Image size 1659x2212:
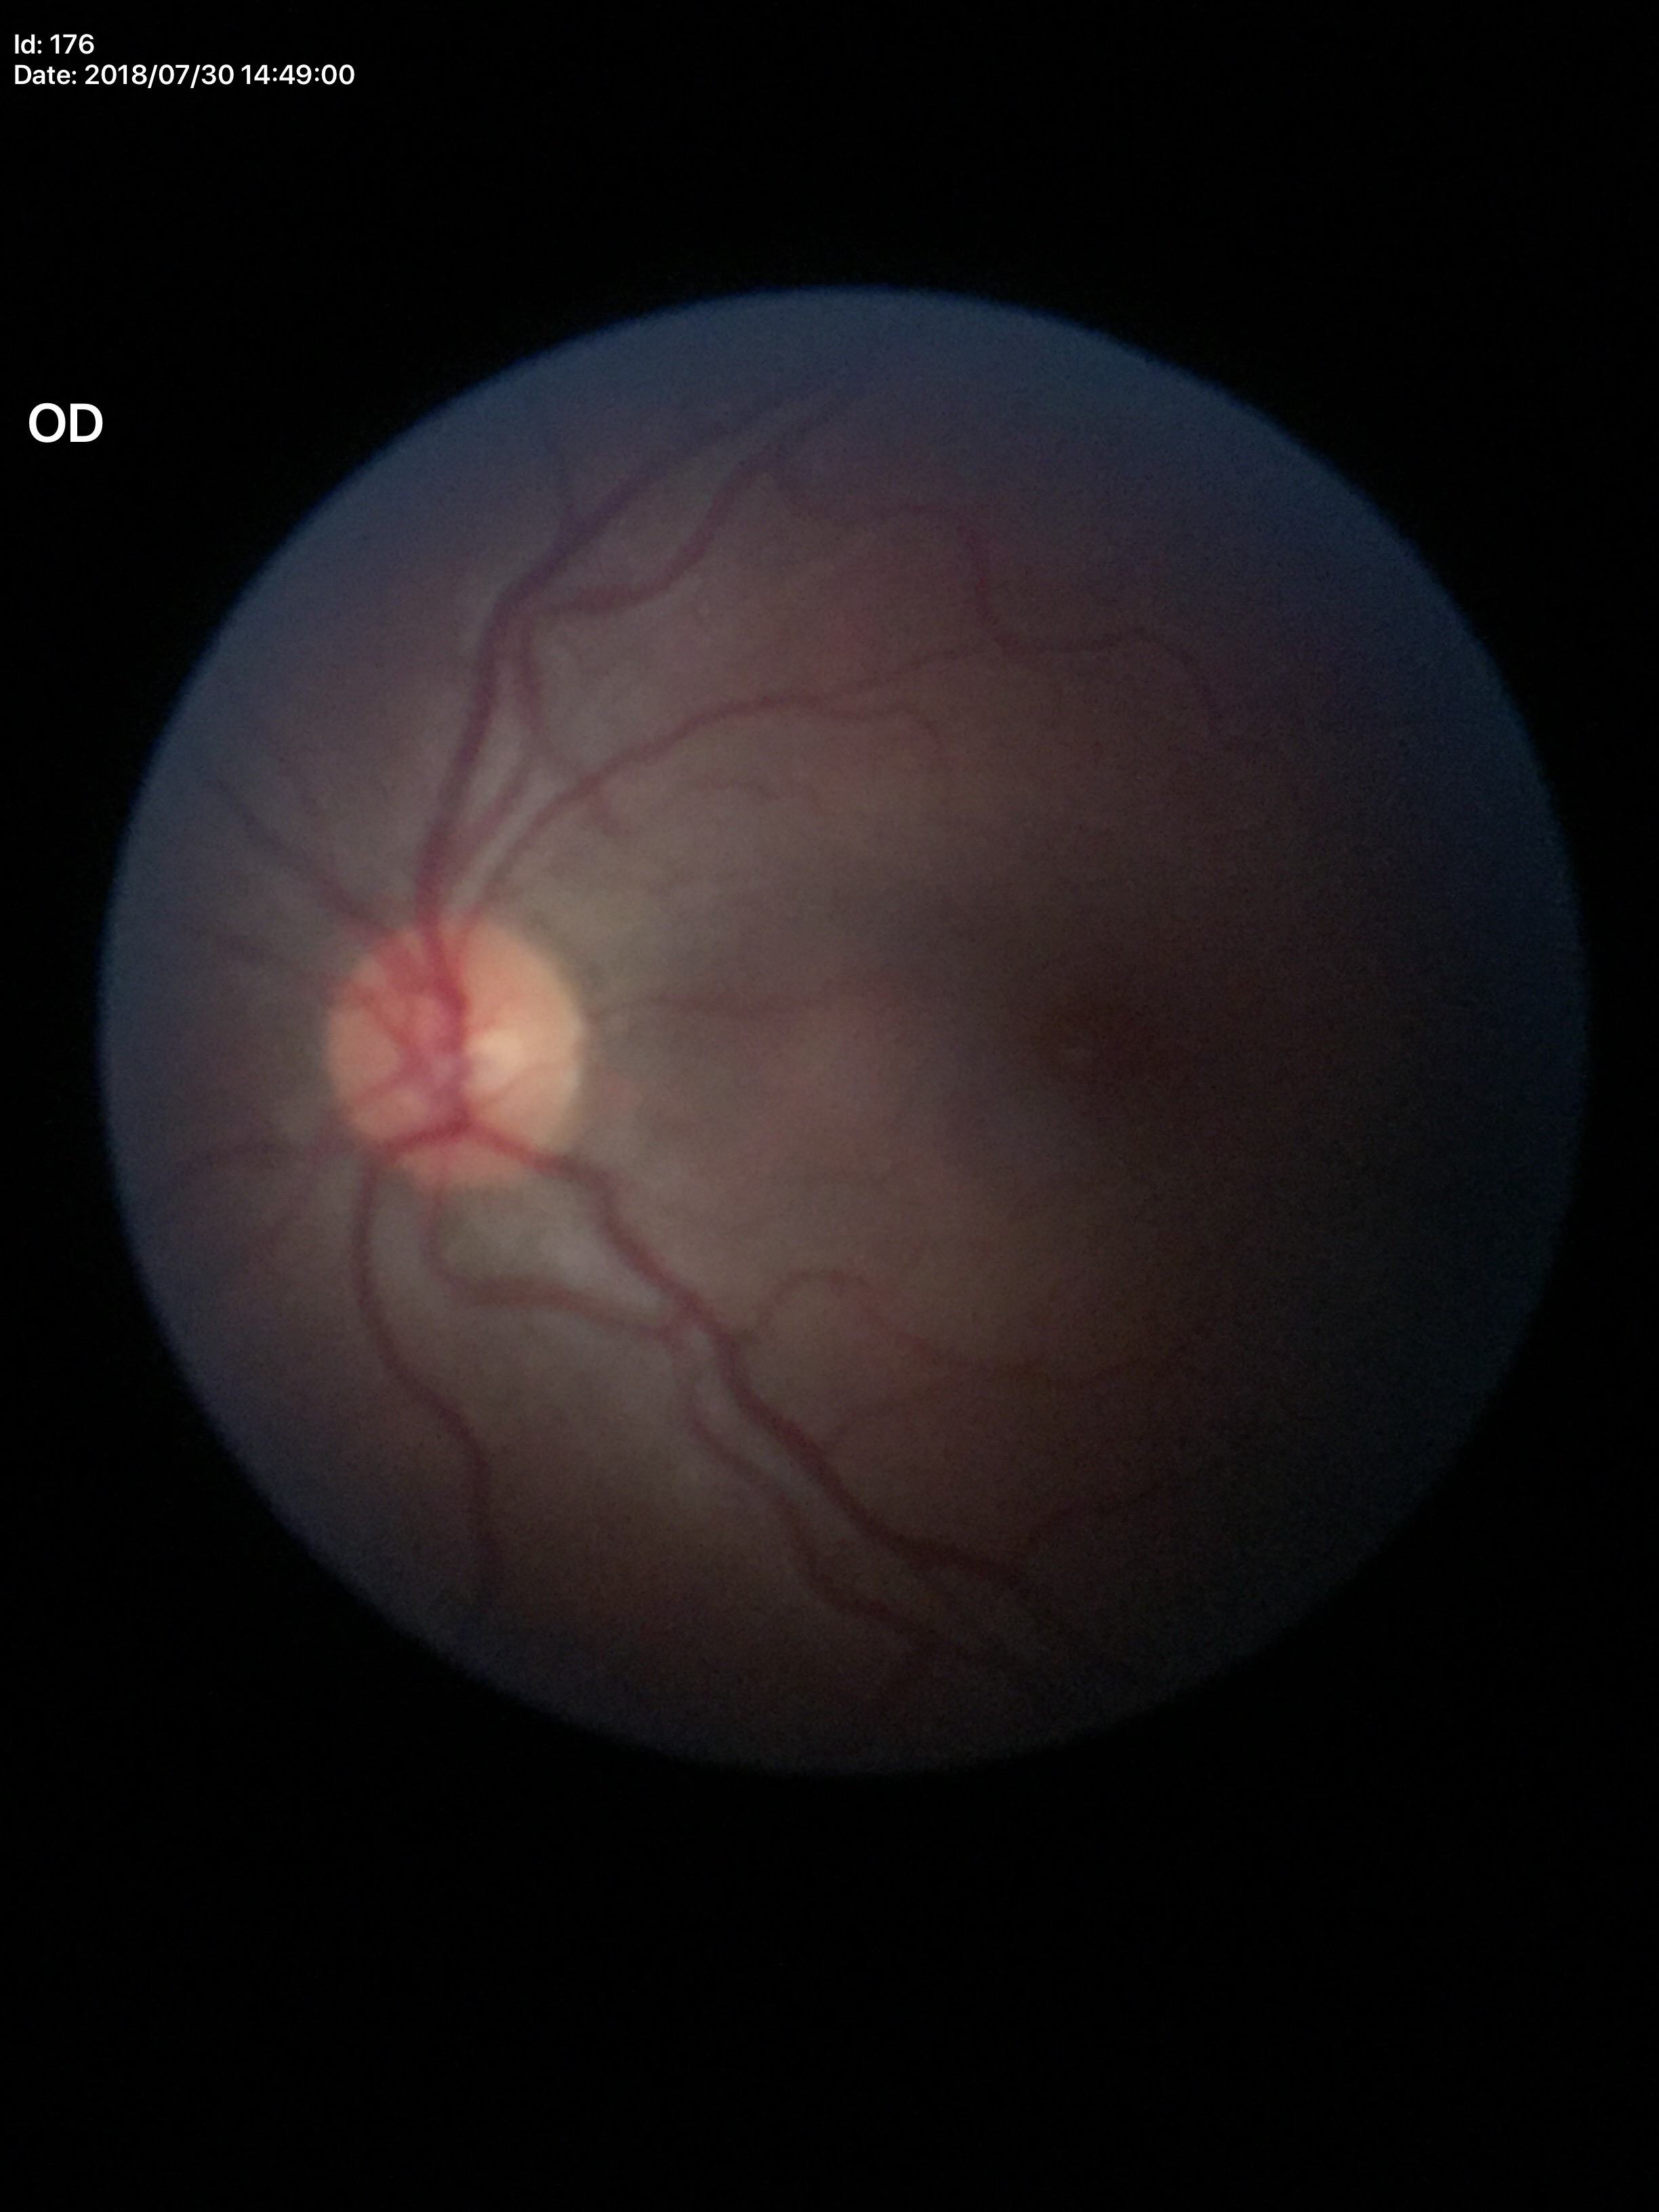

Glaucoma decision=not suspect; vertical C/D ratio=0.50; horizontal C/D ratio=0.53; area CDR=0.26